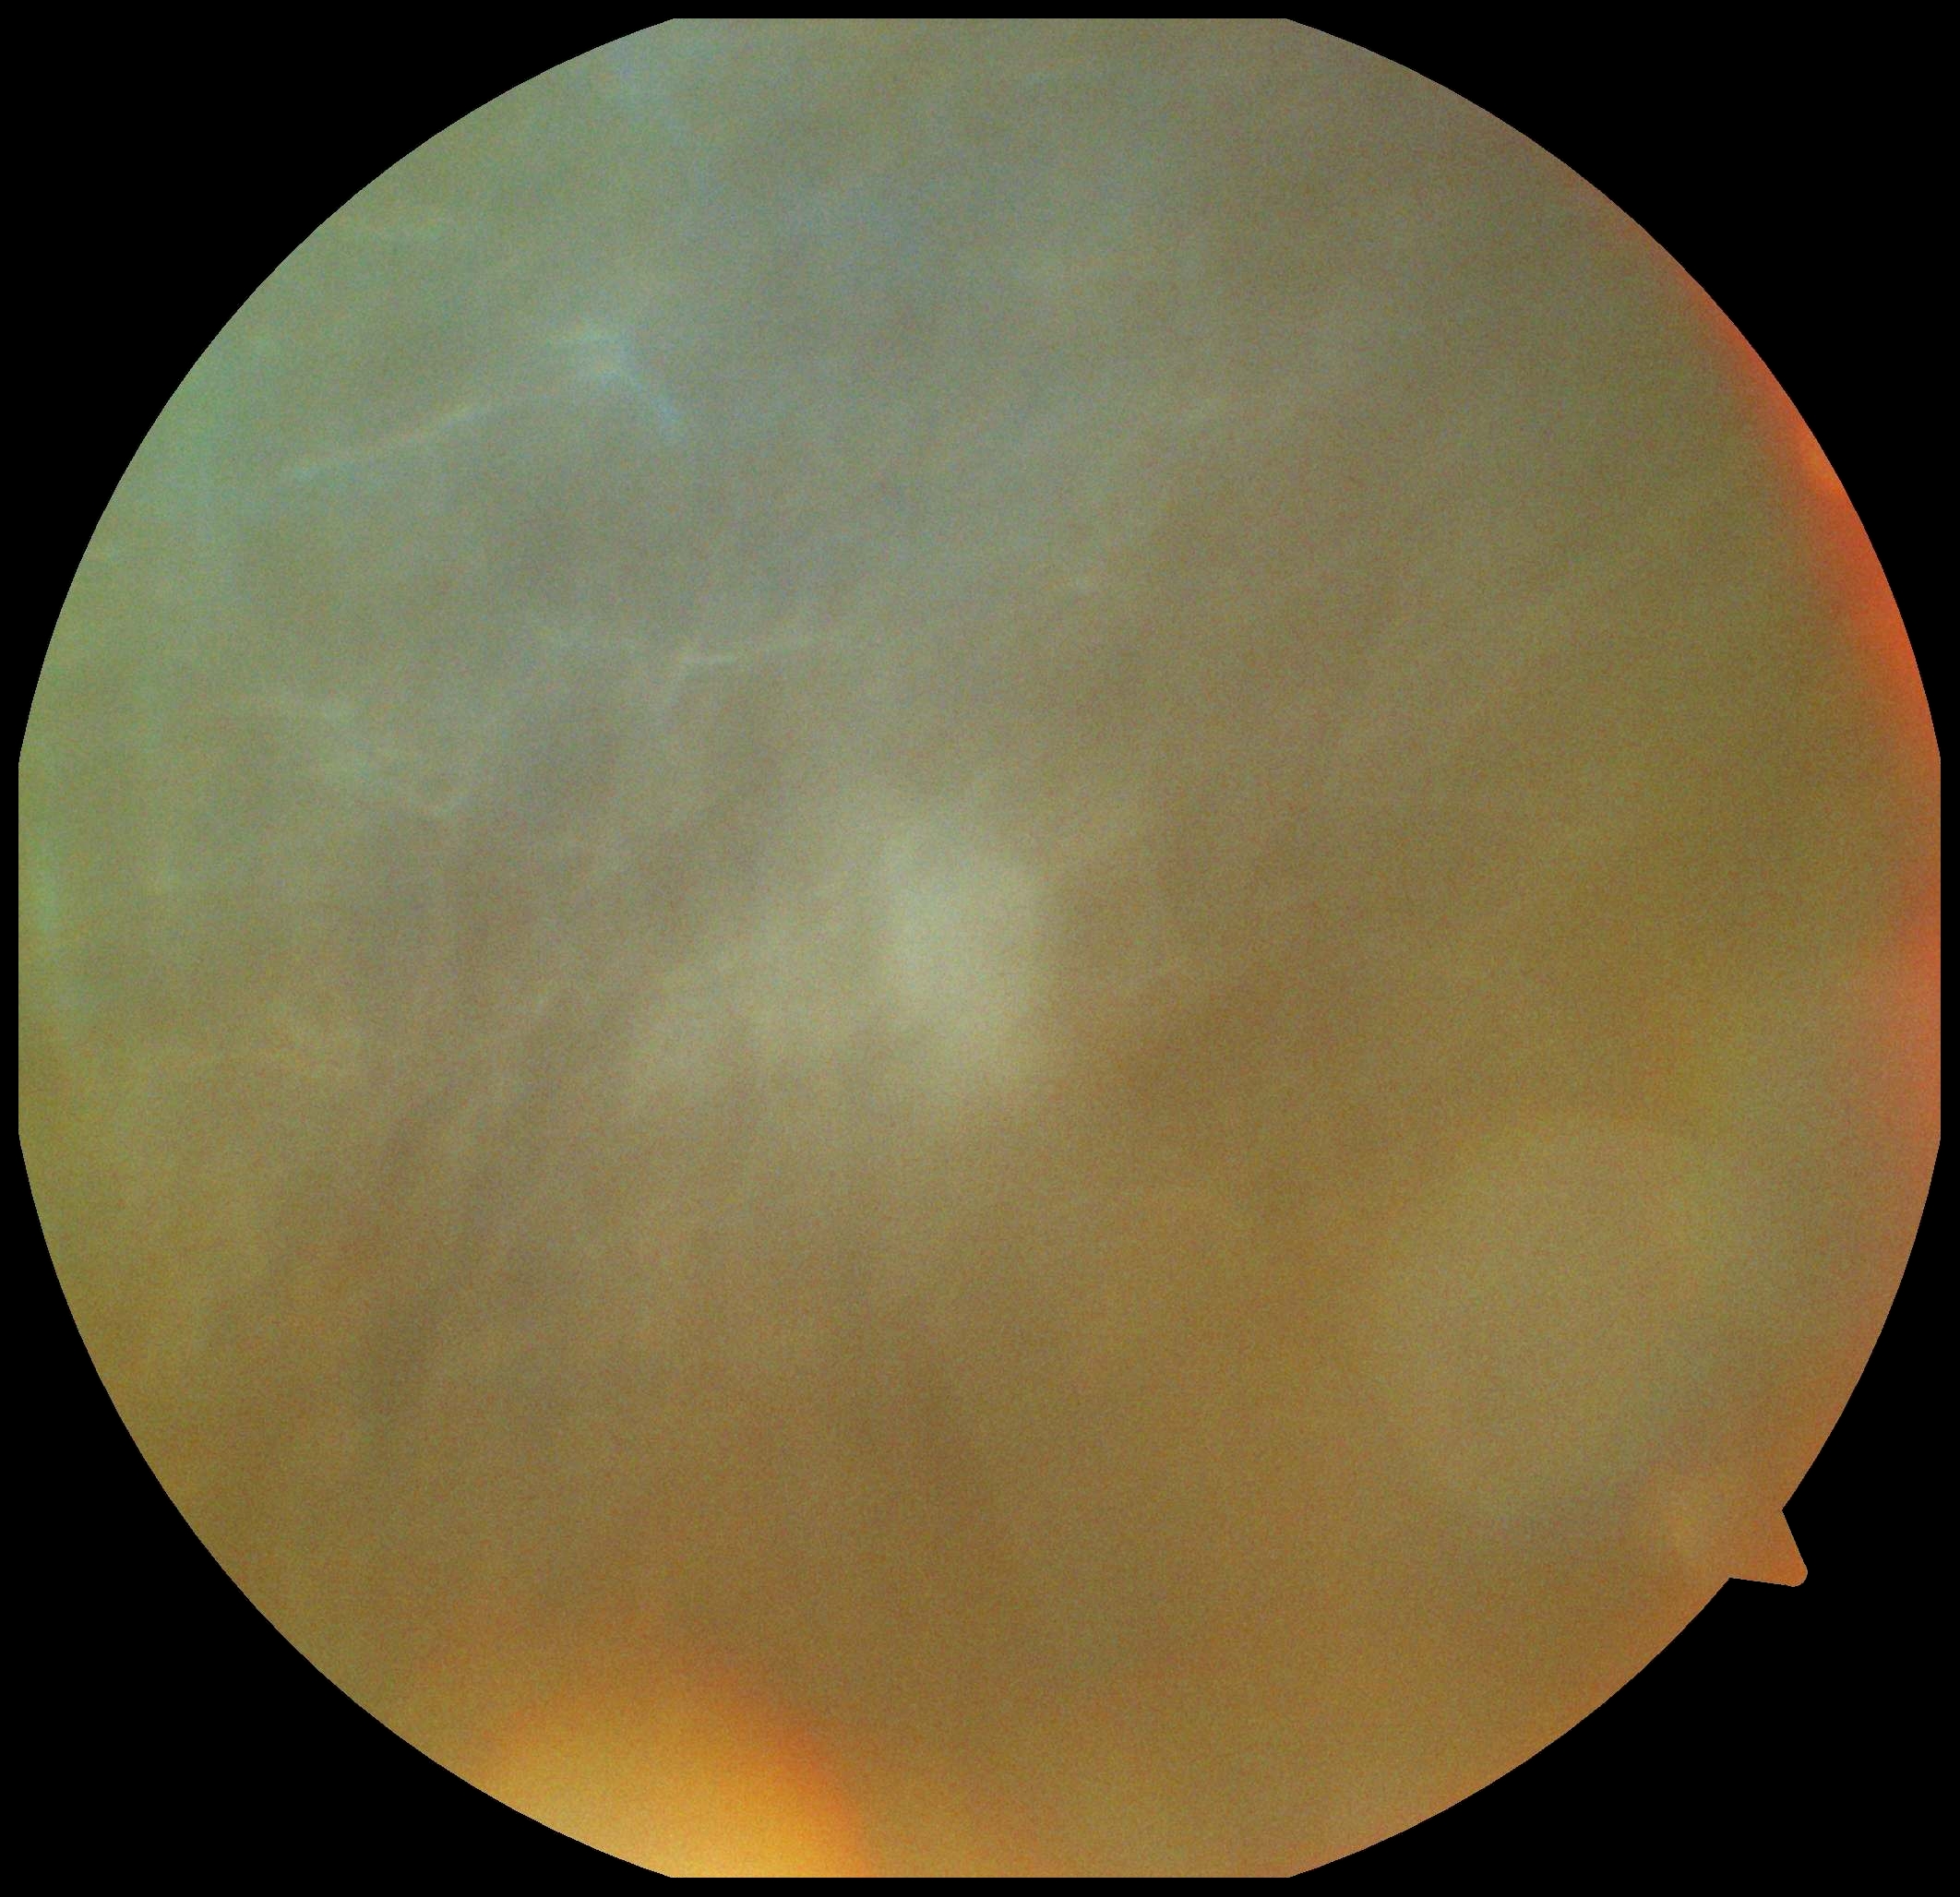

image quality@insufficient; DR grade@ungradable due to poor image quality.